FOV: 45 degrees · color fundus photograph:
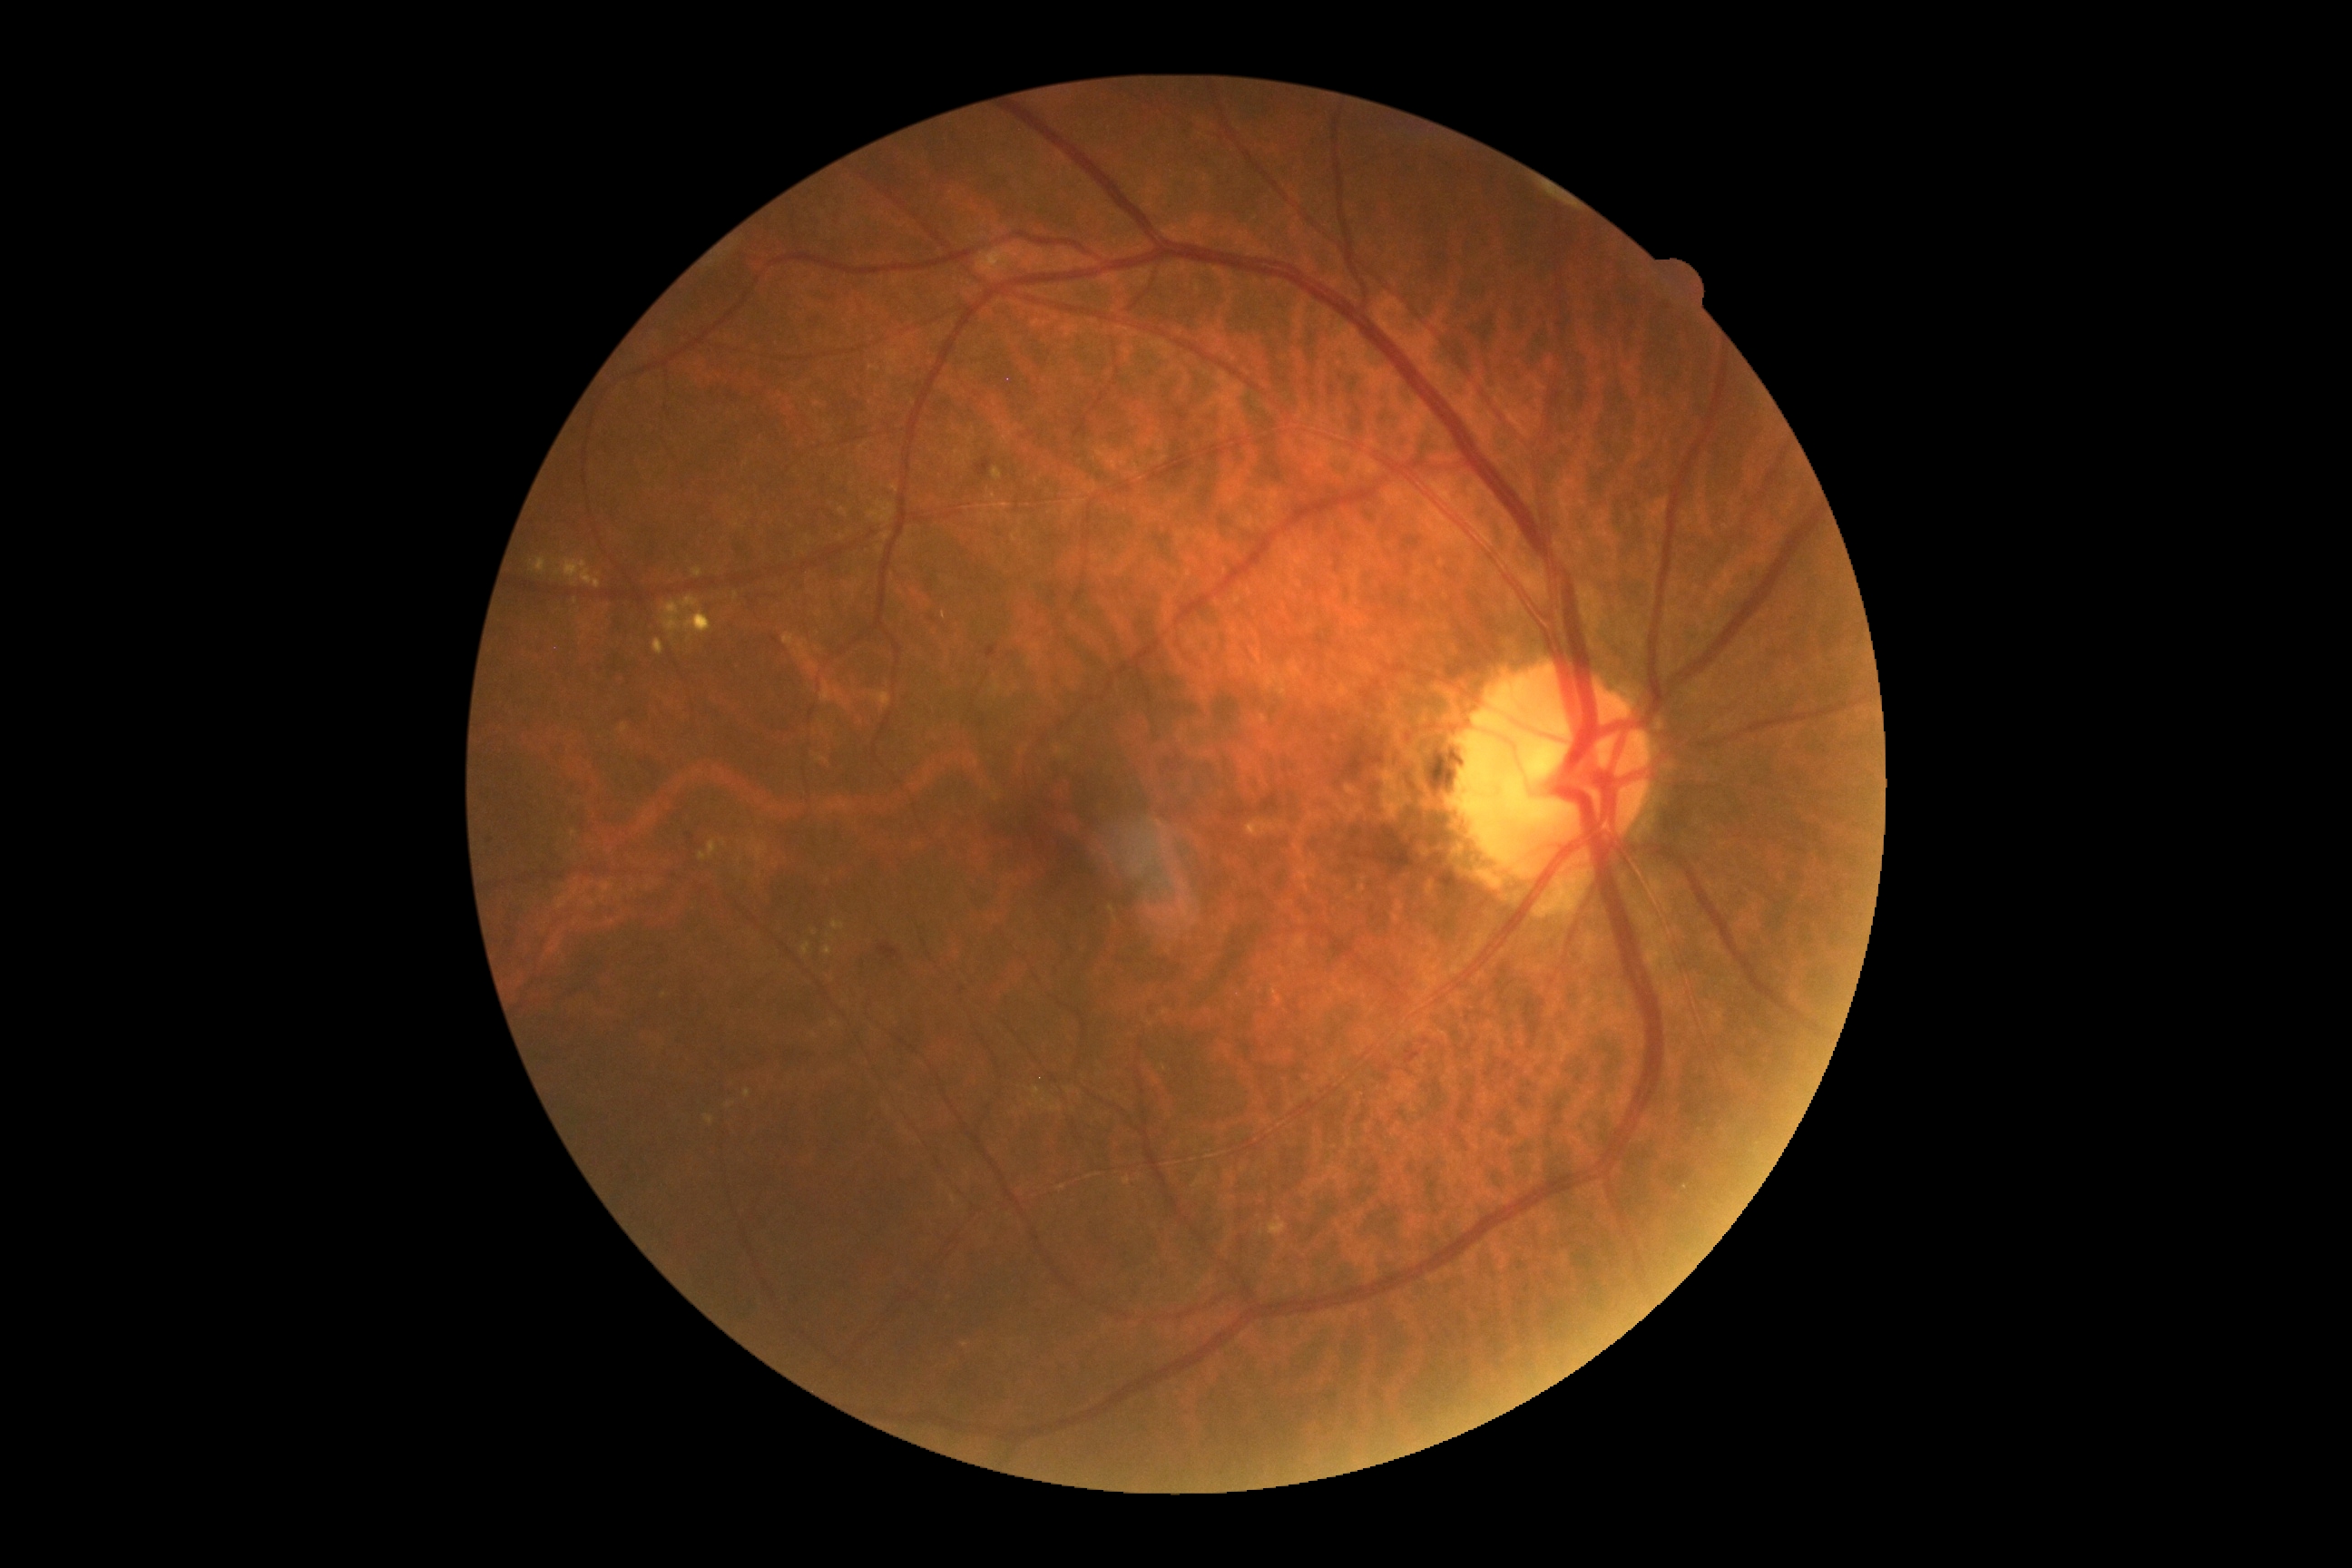 DR stage=moderate NPDR (grade 2).